Diabetic retinopathy graded by the modified Davis classification · no pharmacologic dilation · 45° FOV
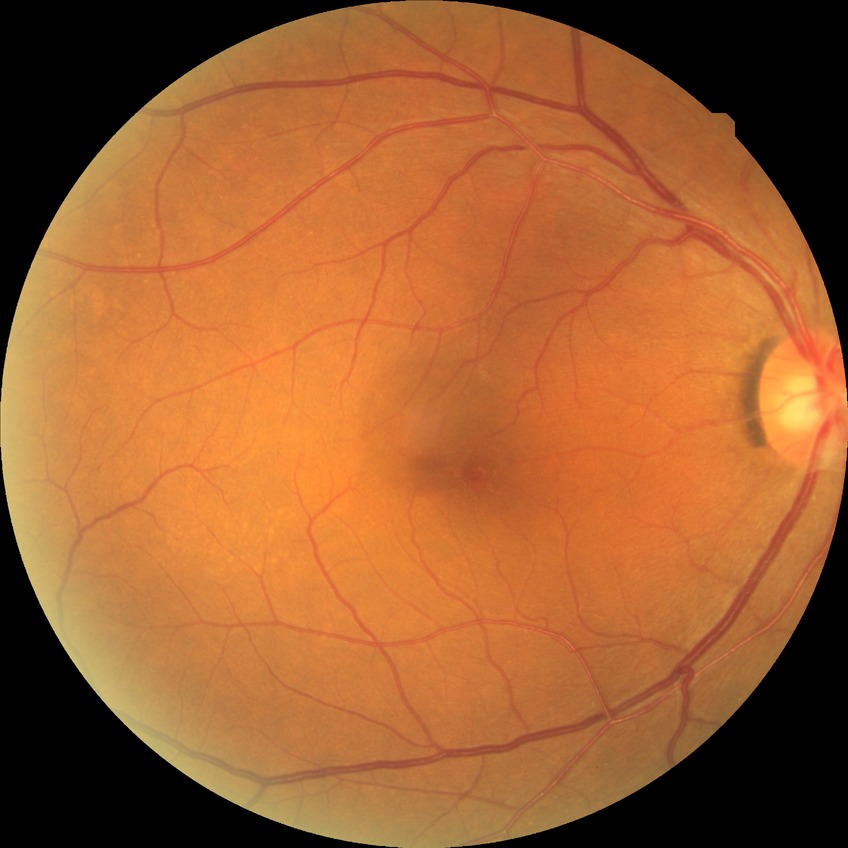 Annotations:
* diabetic retinopathy (DR): no diabetic retinopathy (NDR)